Image size 512x512:
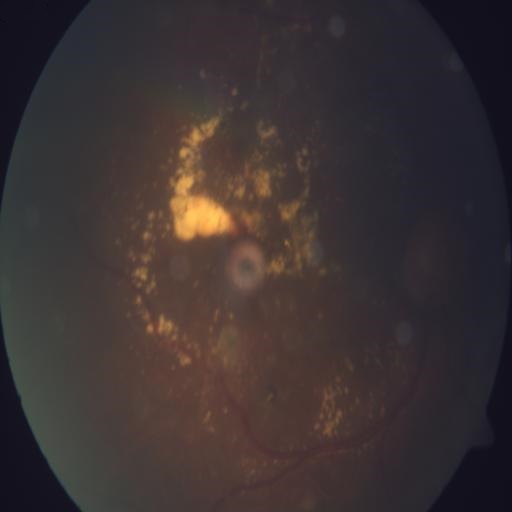 Findings consistent with exudation (EDN).